Non-mydriatic. 2212x1661px. FOV: 30 degrees.
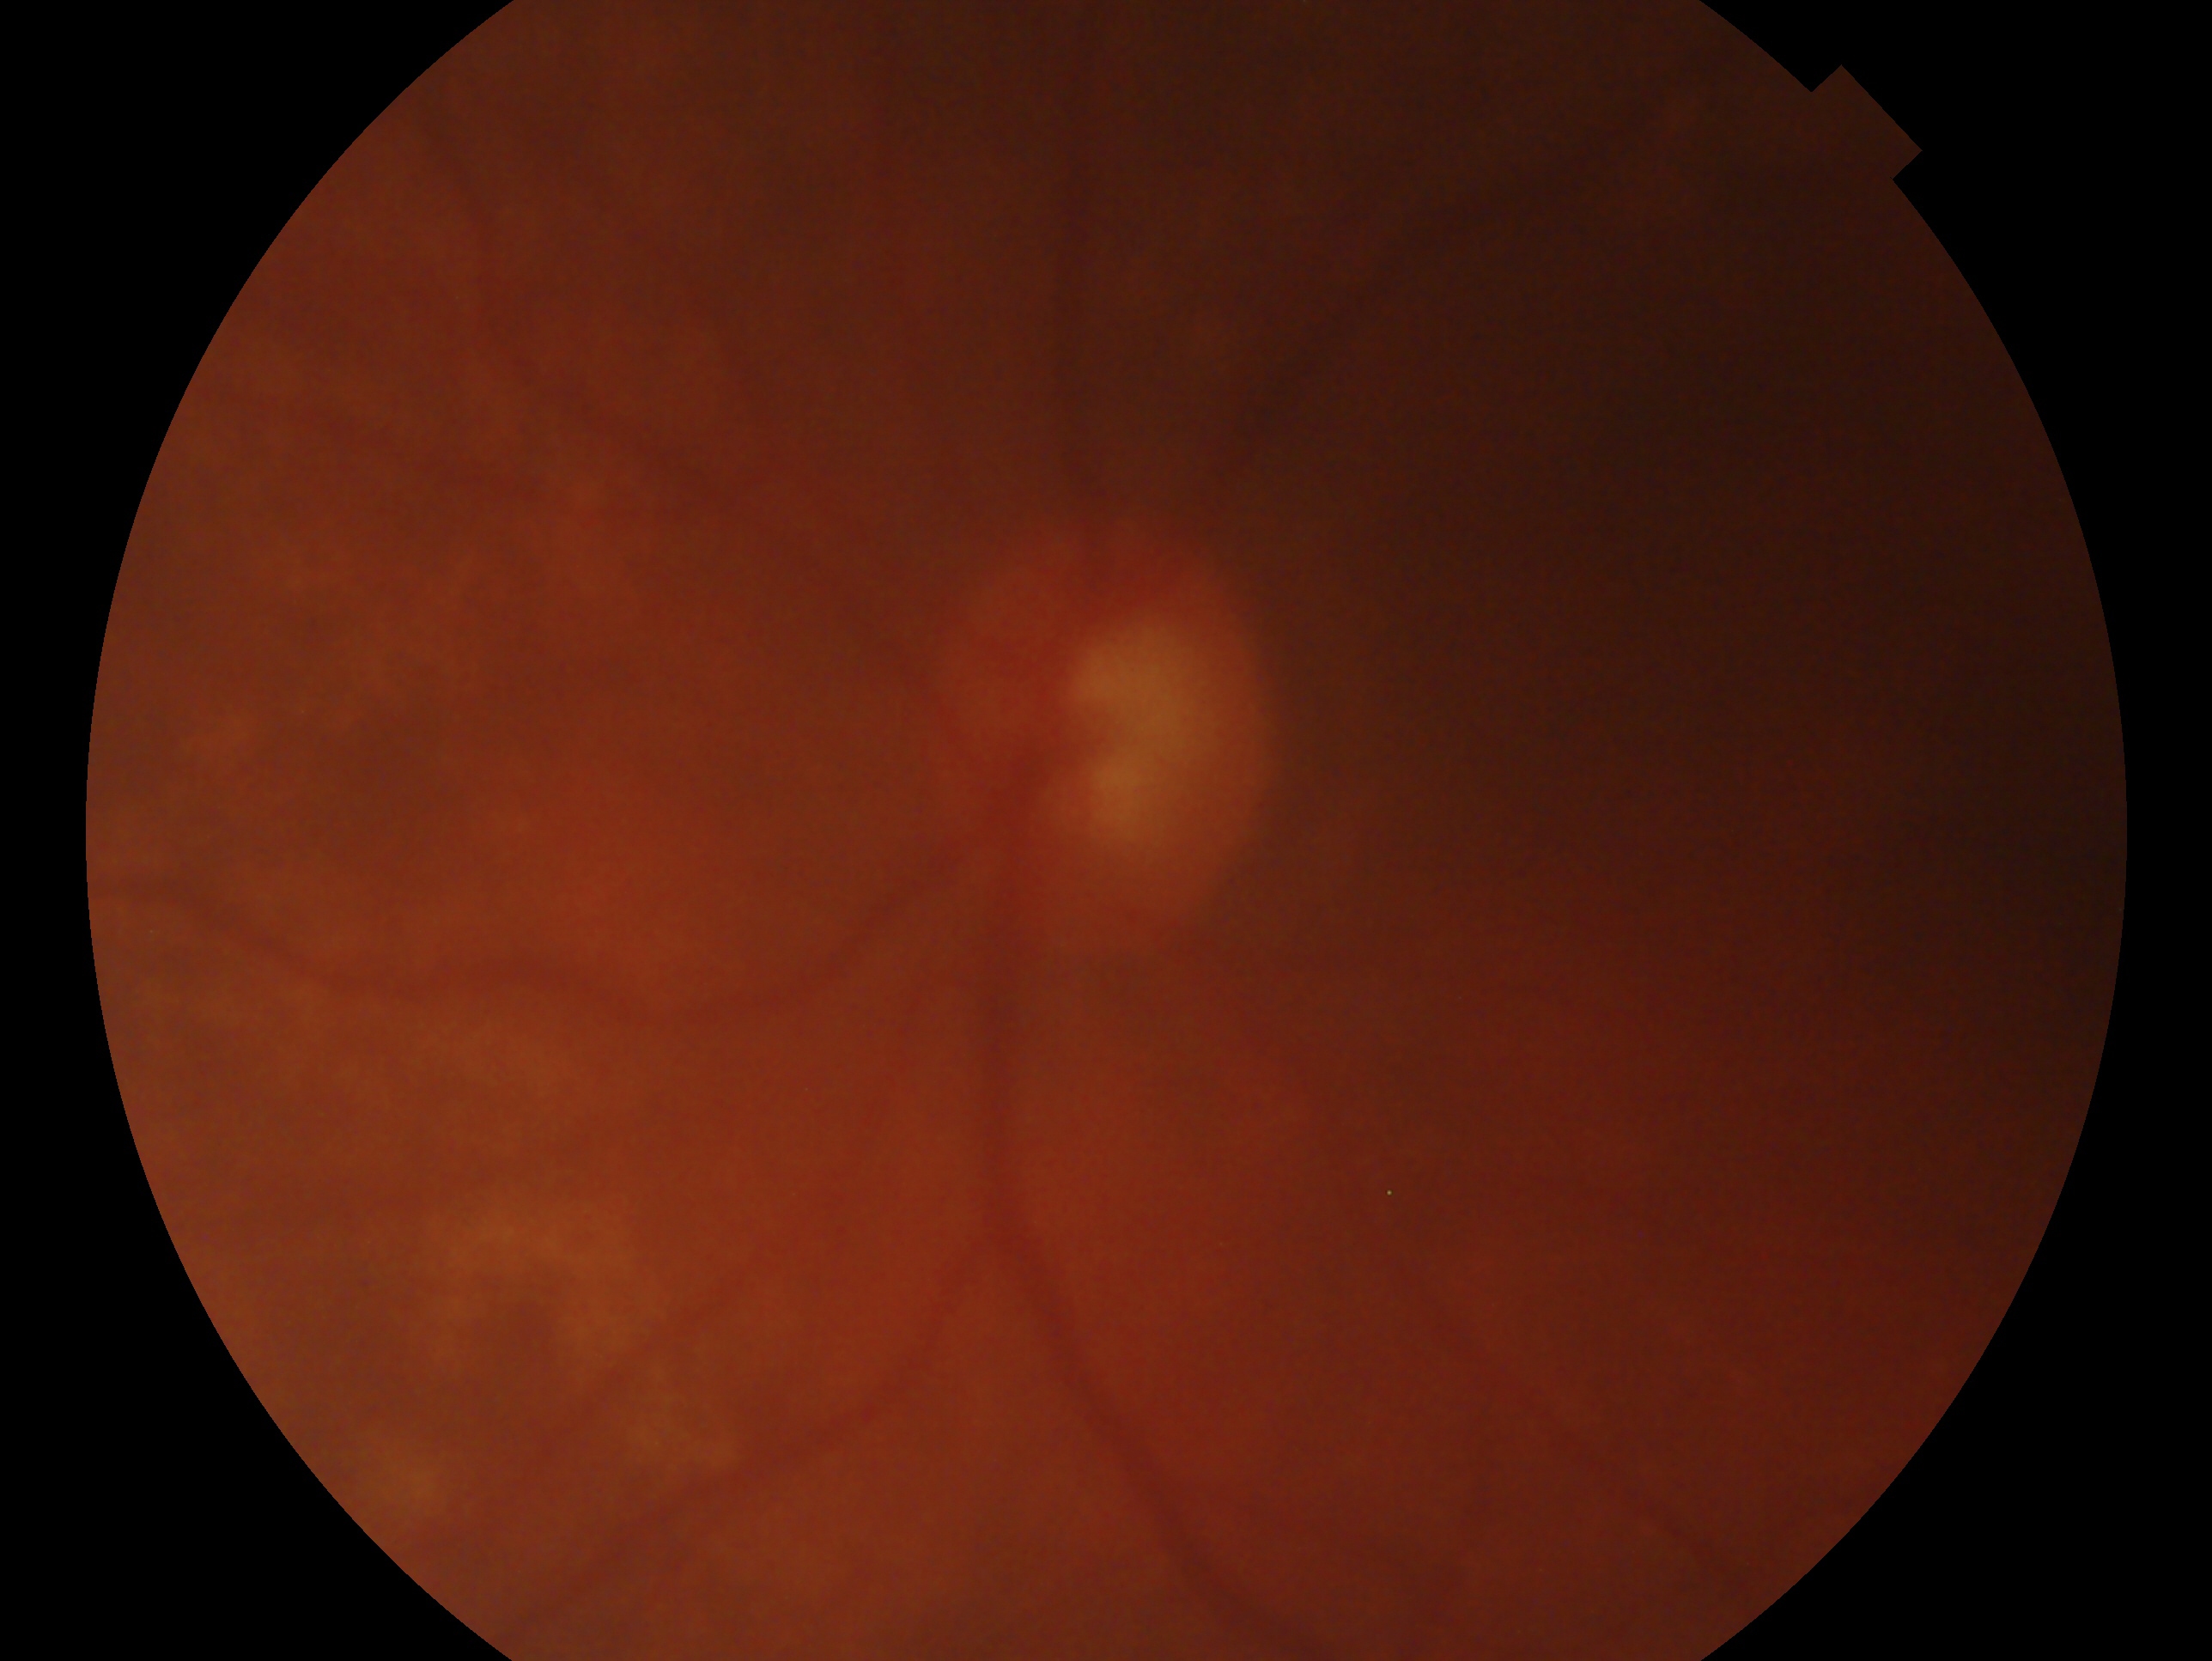

Findings:
- glaucoma status — glaucoma — clinically confirmed glaucoma with characteristic optic nerve damage
- laterality — left eye